2352x1568.
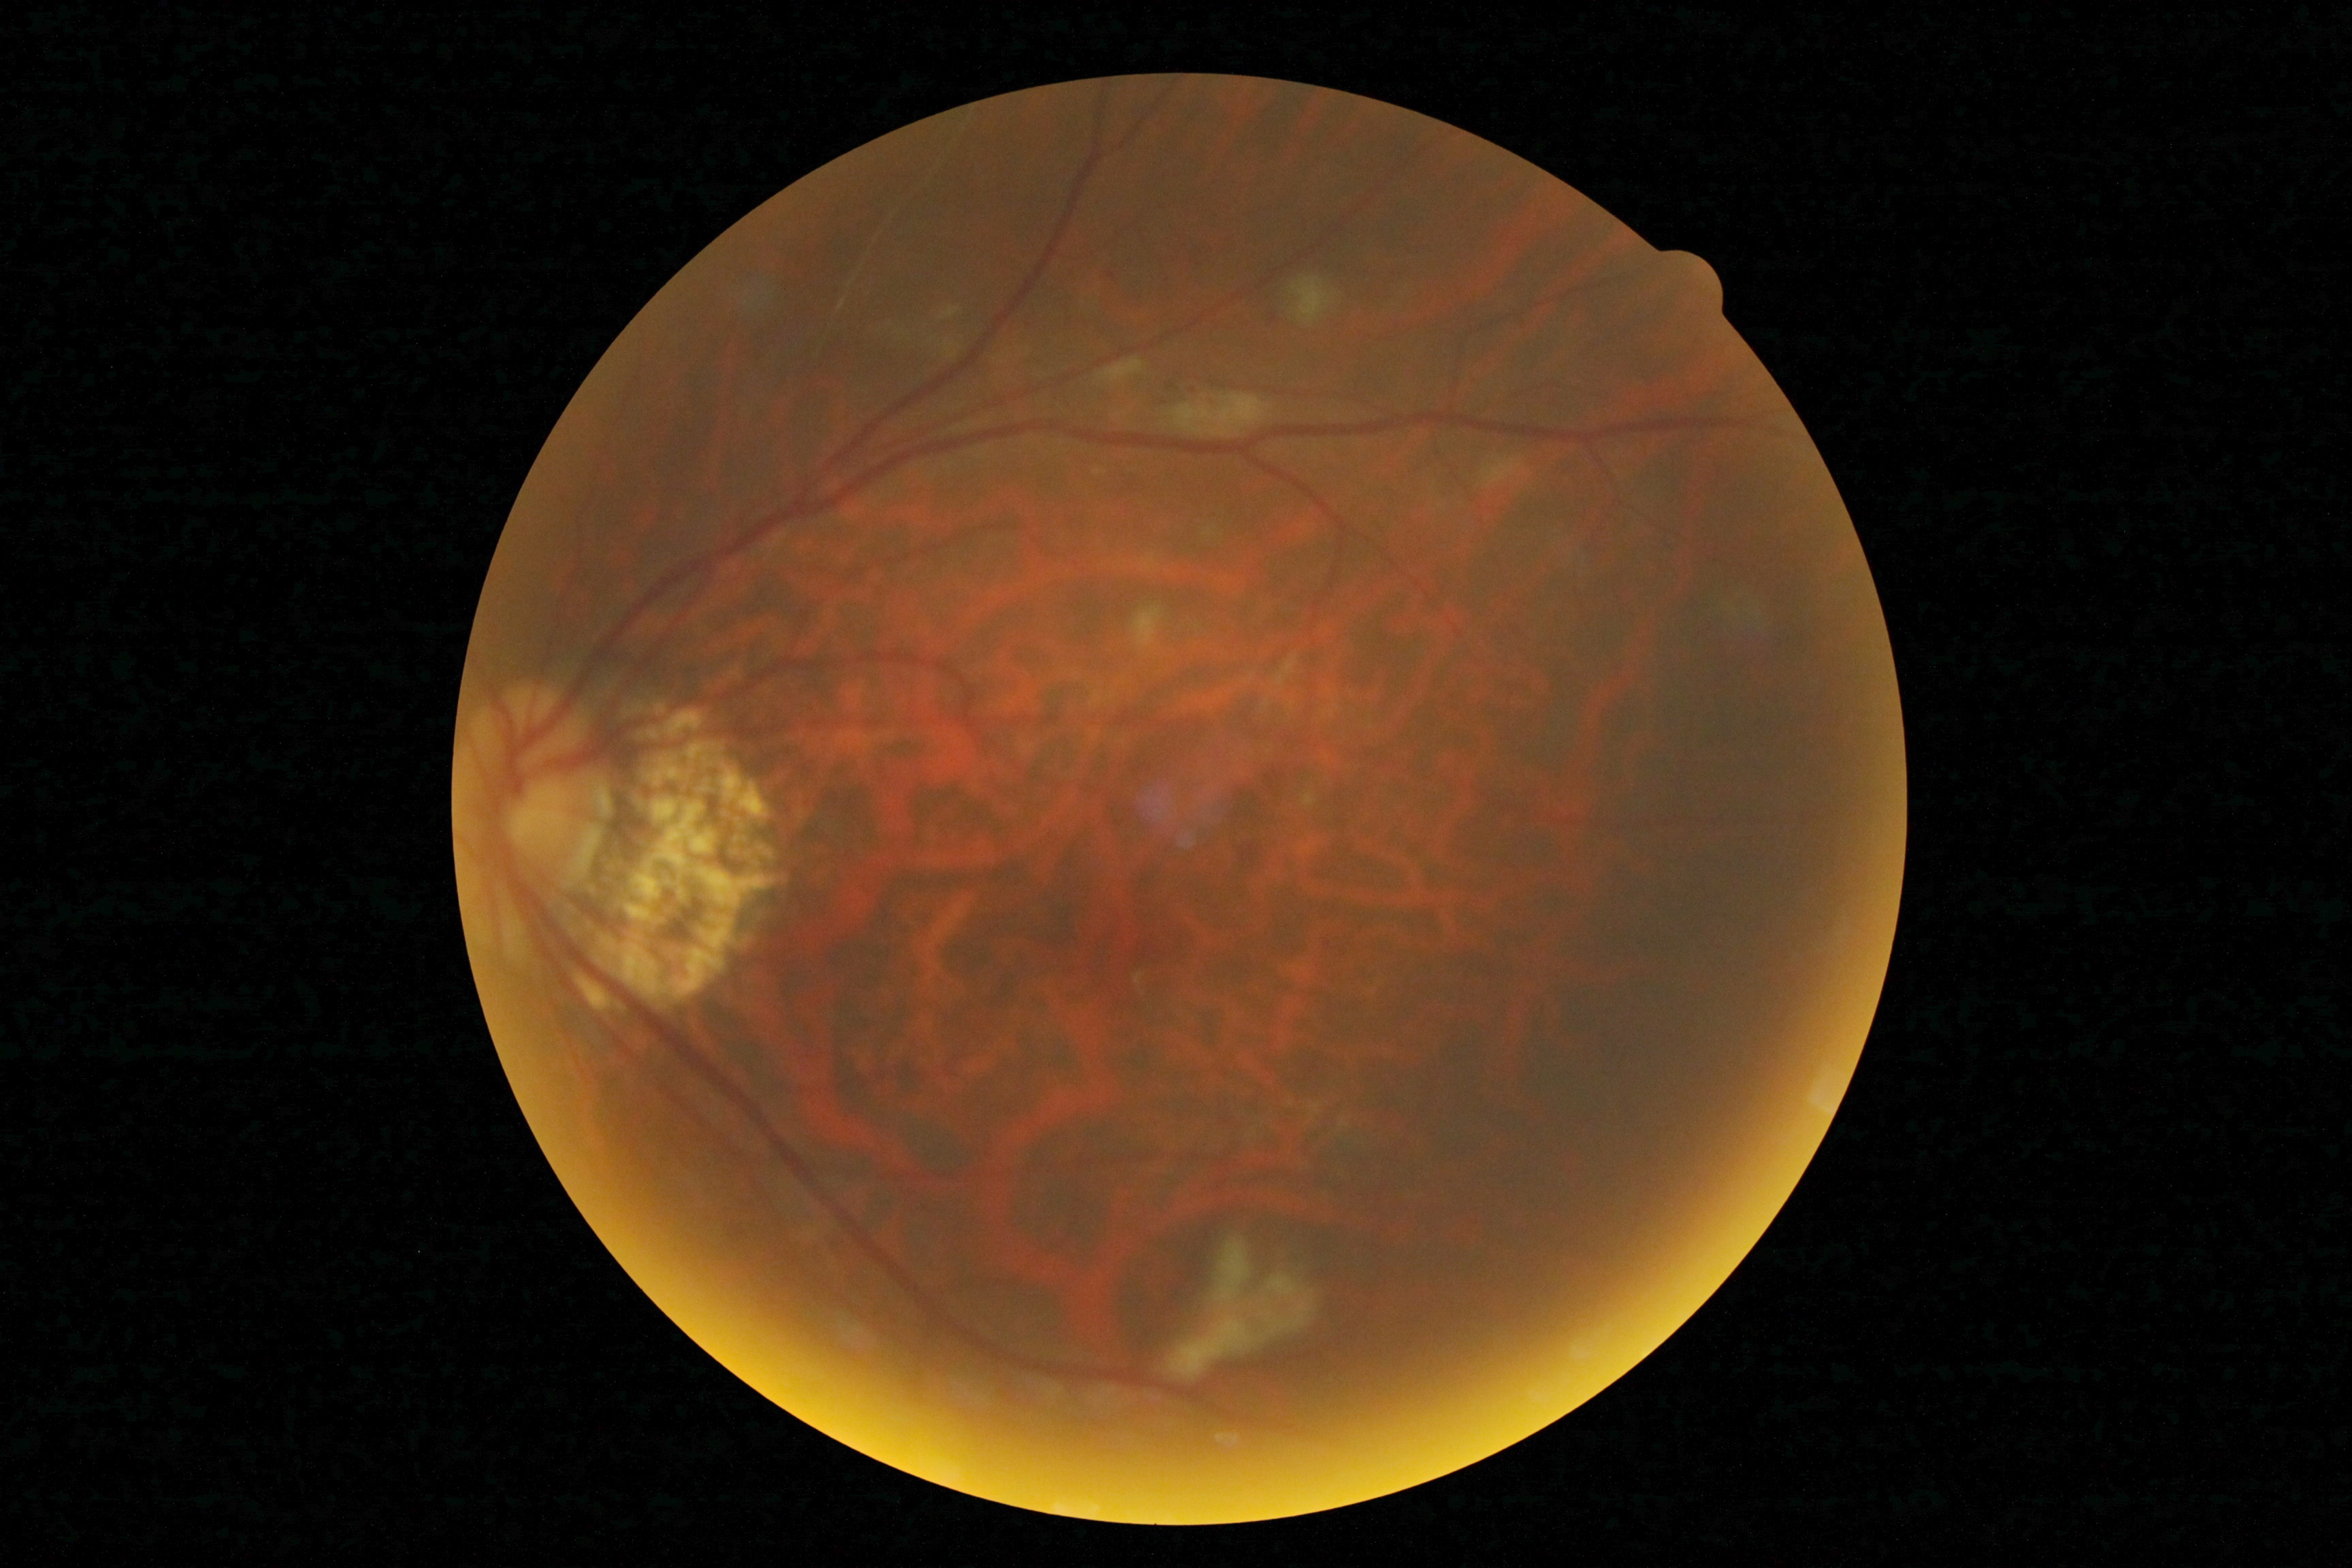 – DR stage: grade 2 (moderate NPDR)
– DR class: non-proliferative diabetic retinopathy